Acquired with a NIDEK AFC-230 — 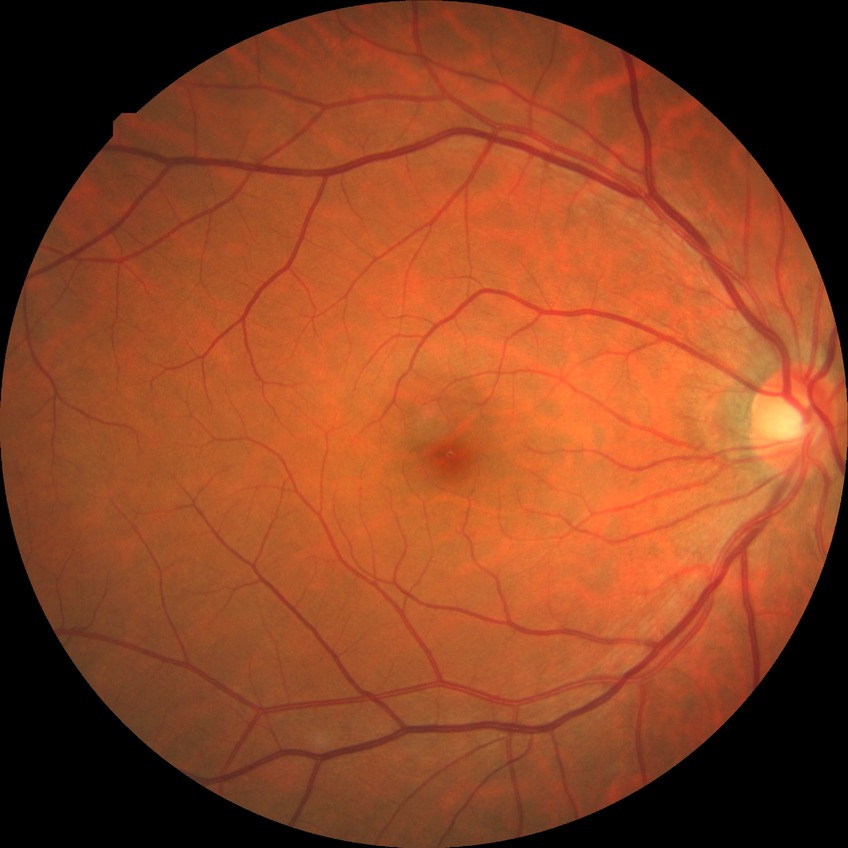 davis_grade: NDR (no diabetic retinopathy)